Phoenix ICON wide-field infant fundus image — 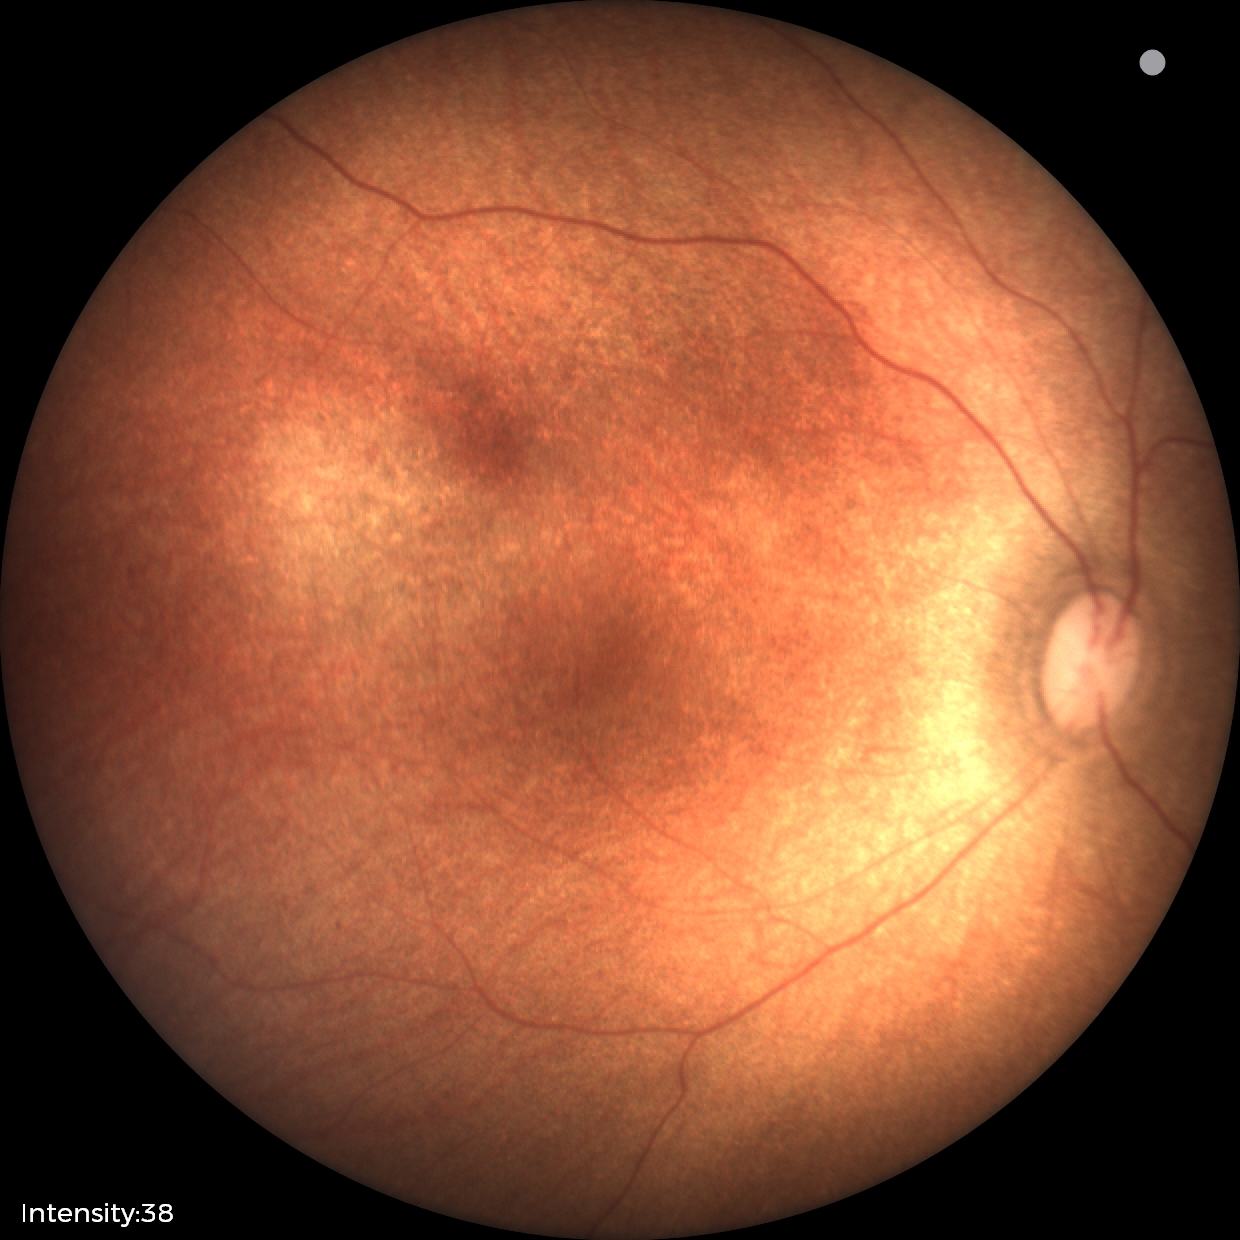

Examination with physiological retinal findings.